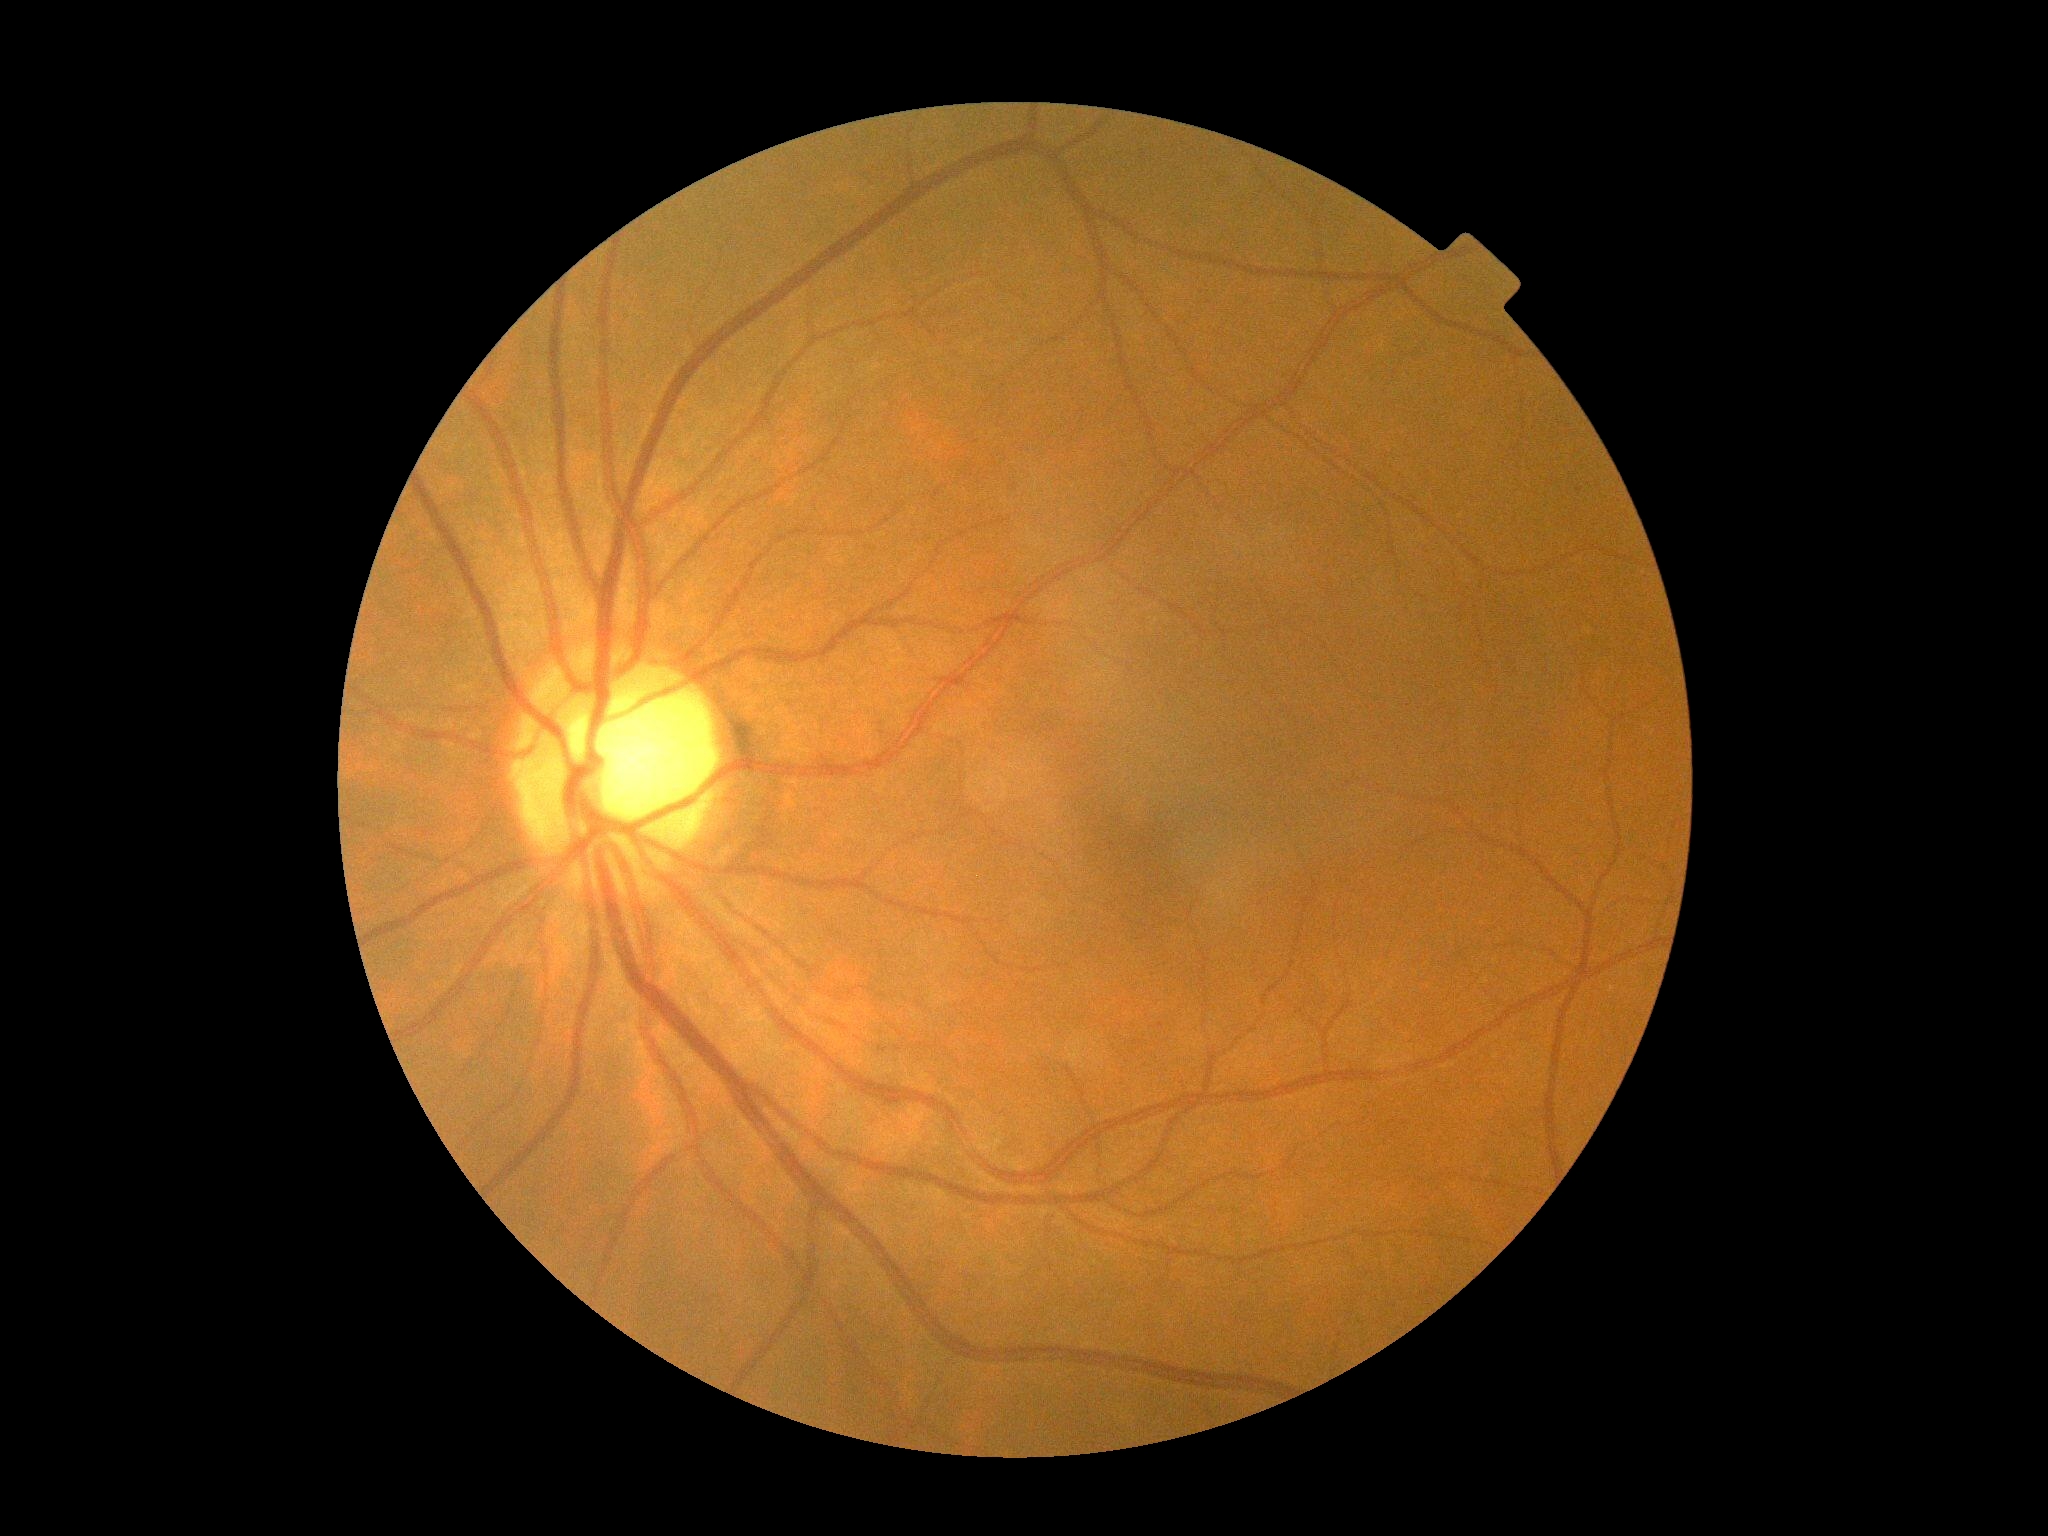

{"dr_grade": "0/4", "dr_impression": "no apparent DR"}